1240x1240px. Infant wide-field retinal image.
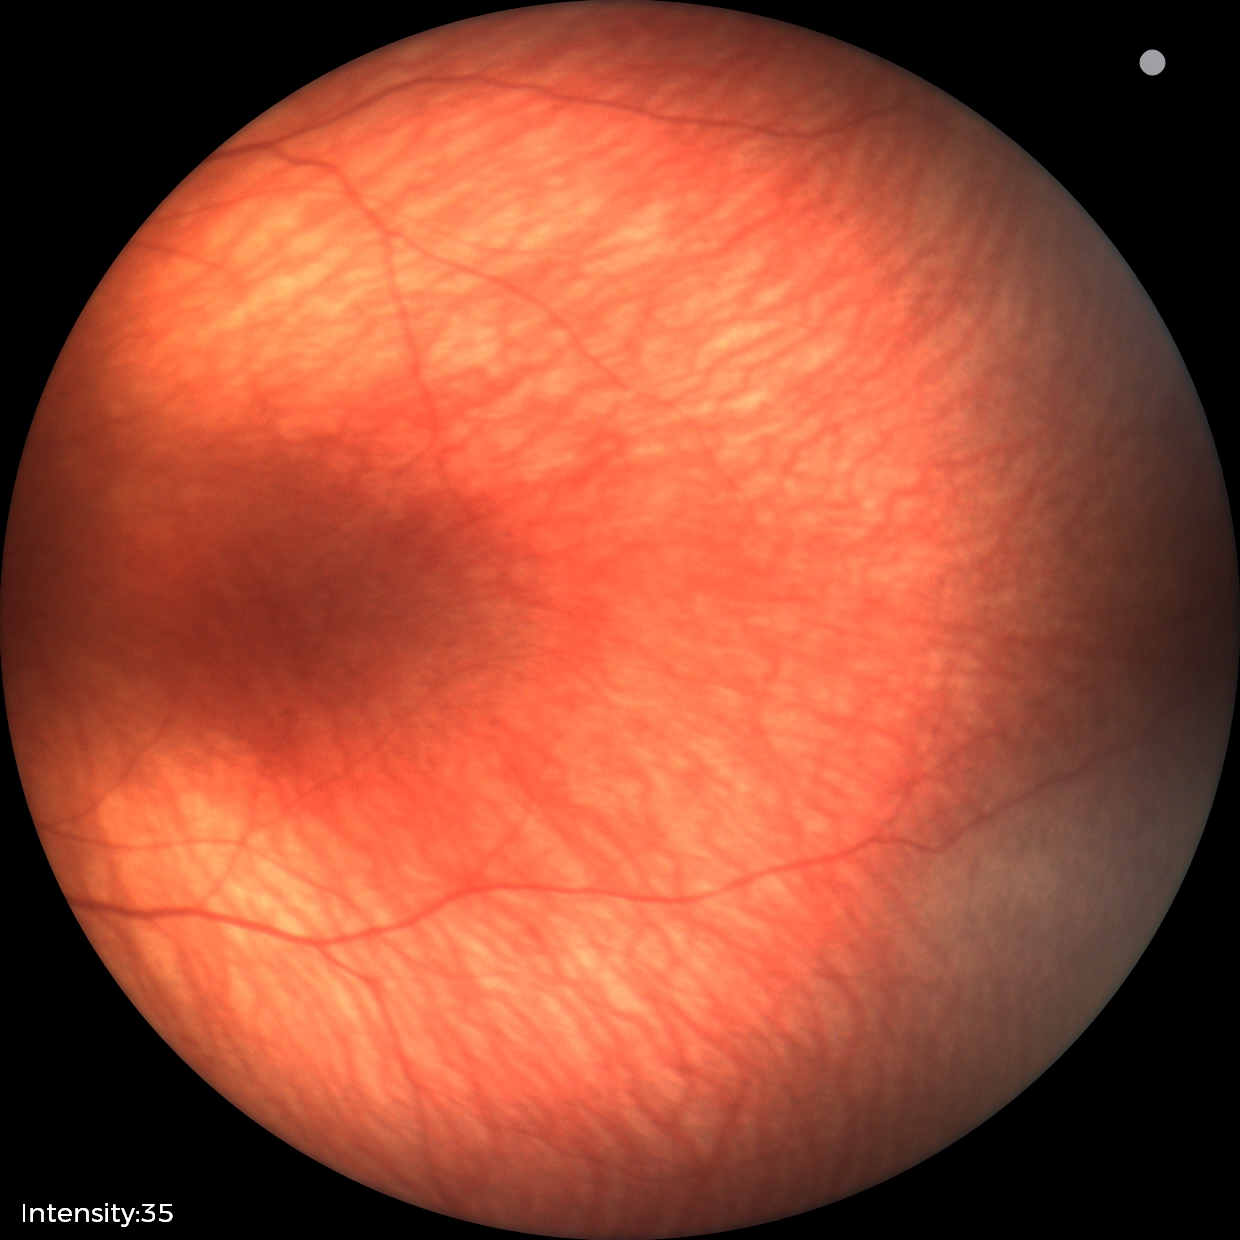
Screening diagnosis: no pathology identified.